Captured on a Topcon TRC-50DX fundus camera. Posterior pole field covering the optic disc and macula.
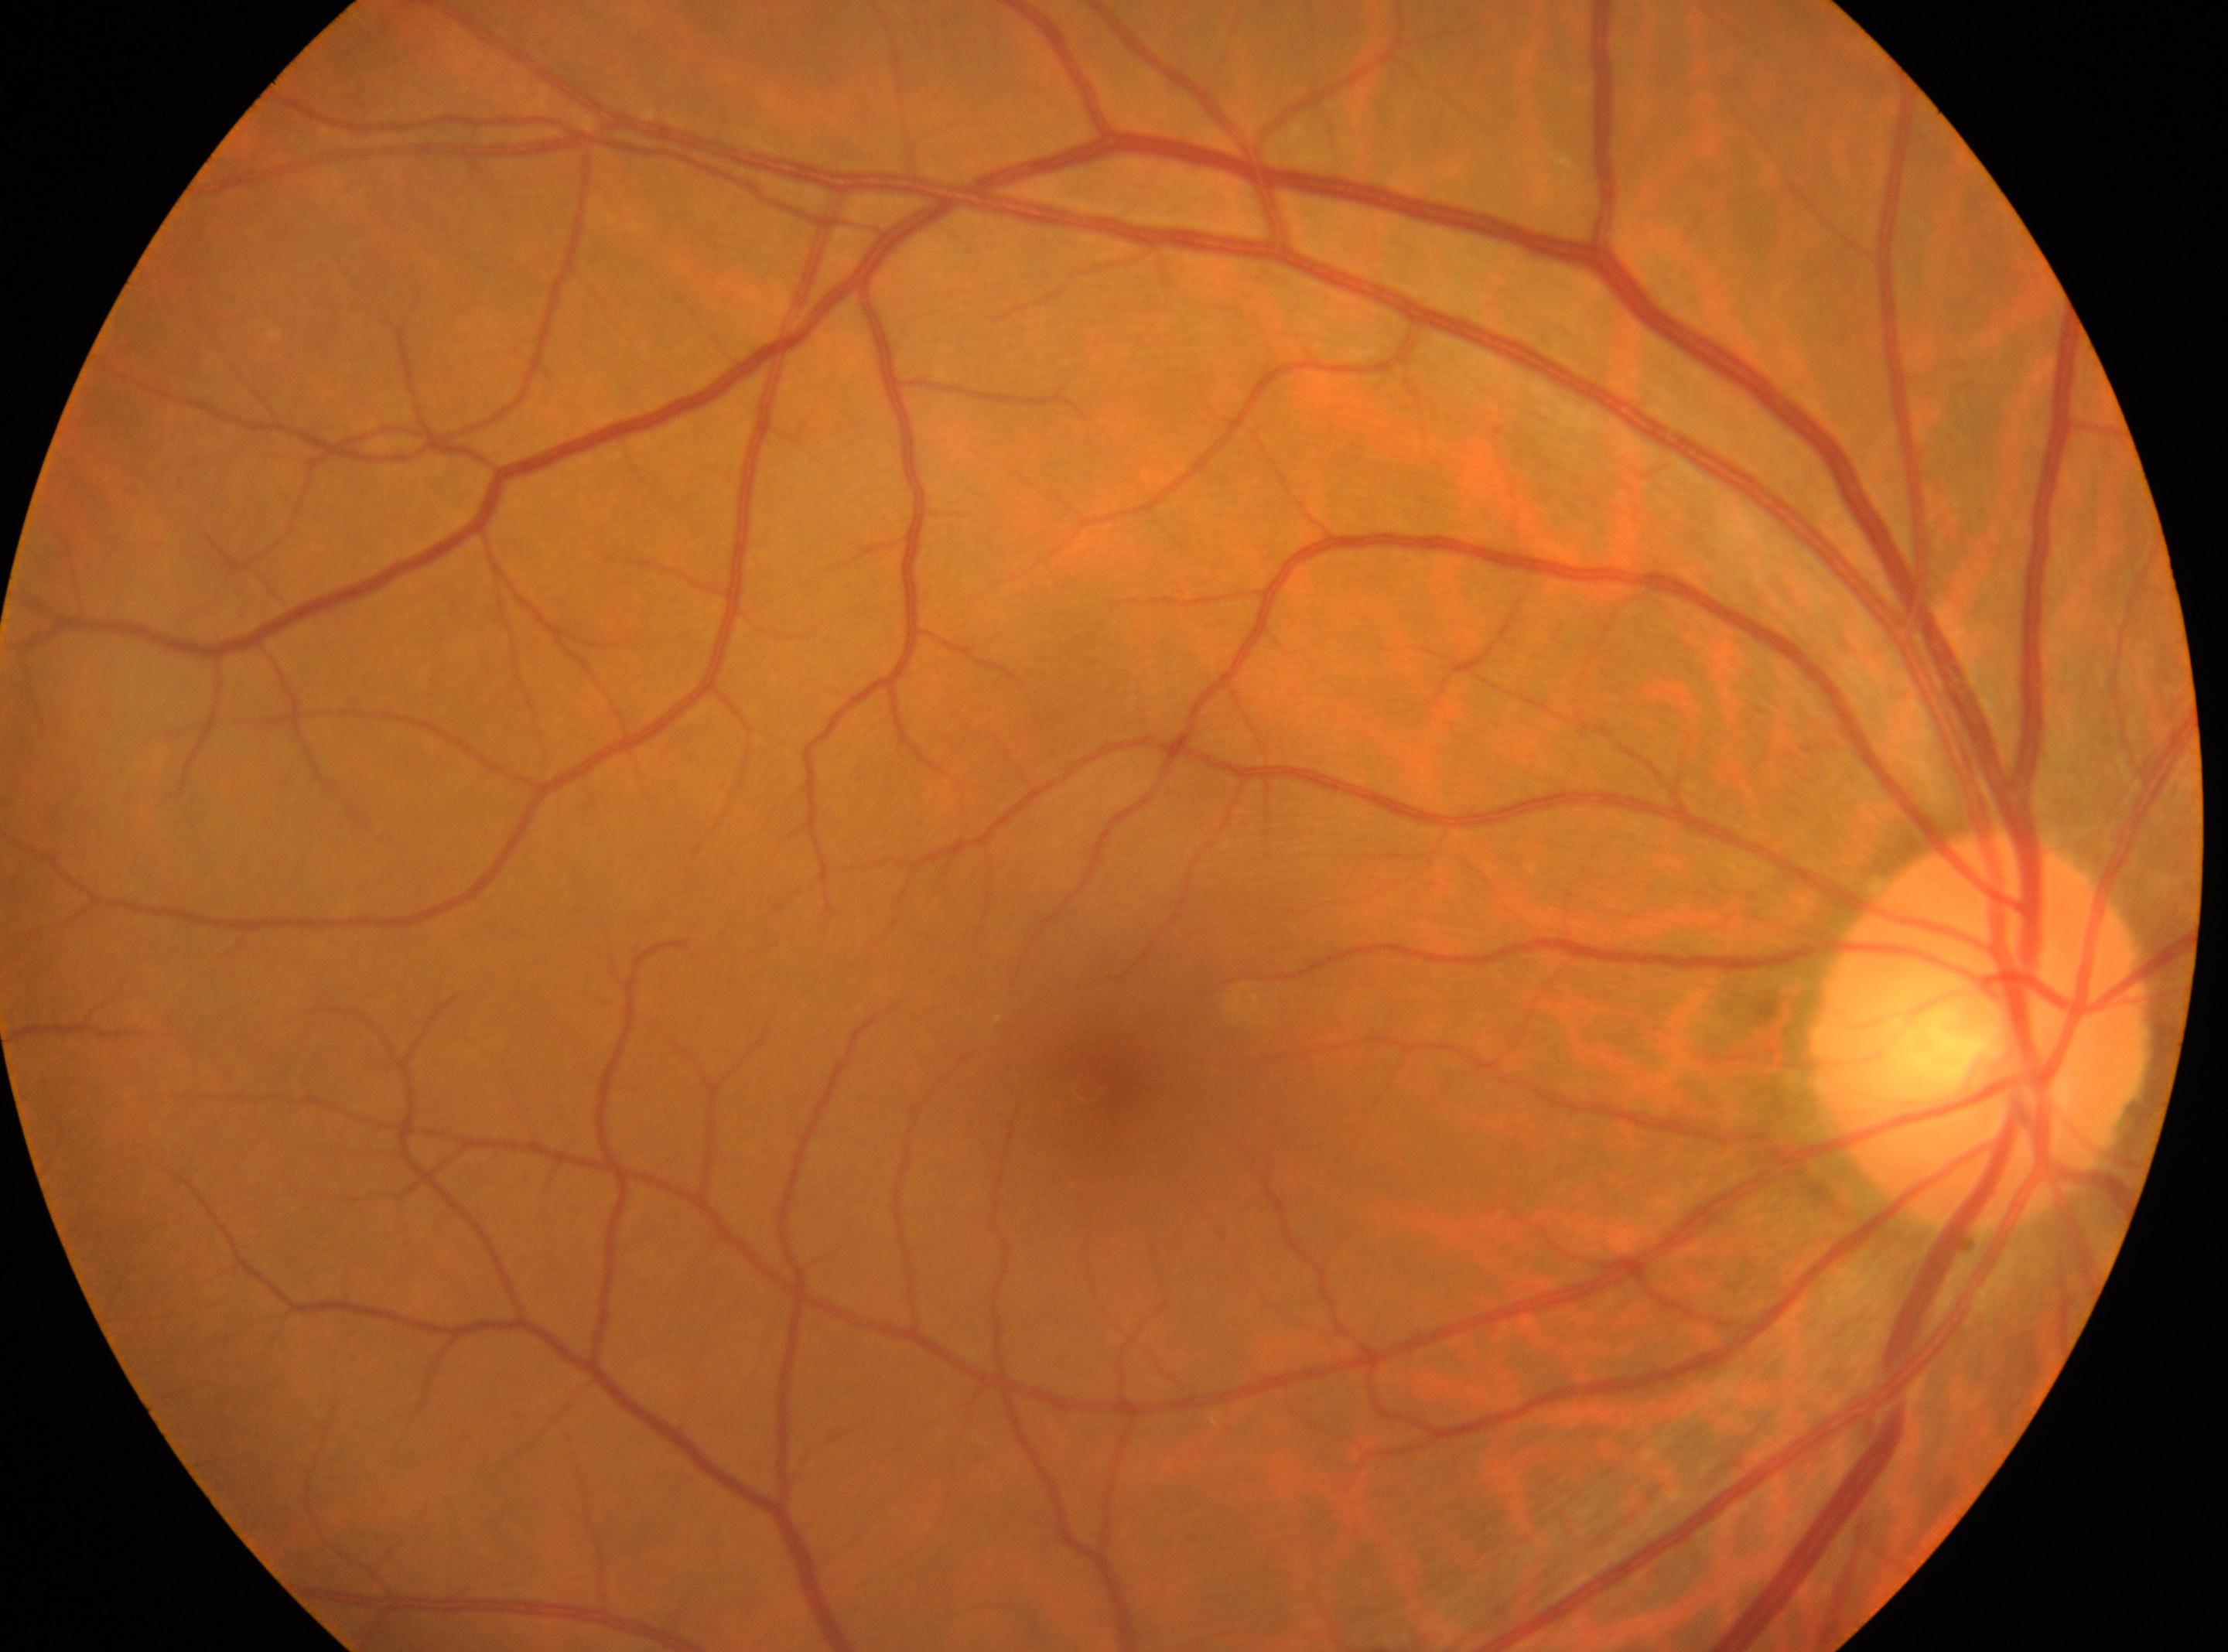
Foveal center located at (1089,1083). The optic disc is at (1982,1033). The image shows the right eye. Diabetic retinopathy severity: grade 0 (no apparent retinopathy) — no visible signs of diabetic retinopathy.